Wide-field fundus image from infant ROP screening. Captured with the Phoenix ICON (100° field of view). Image size 1240x1240.
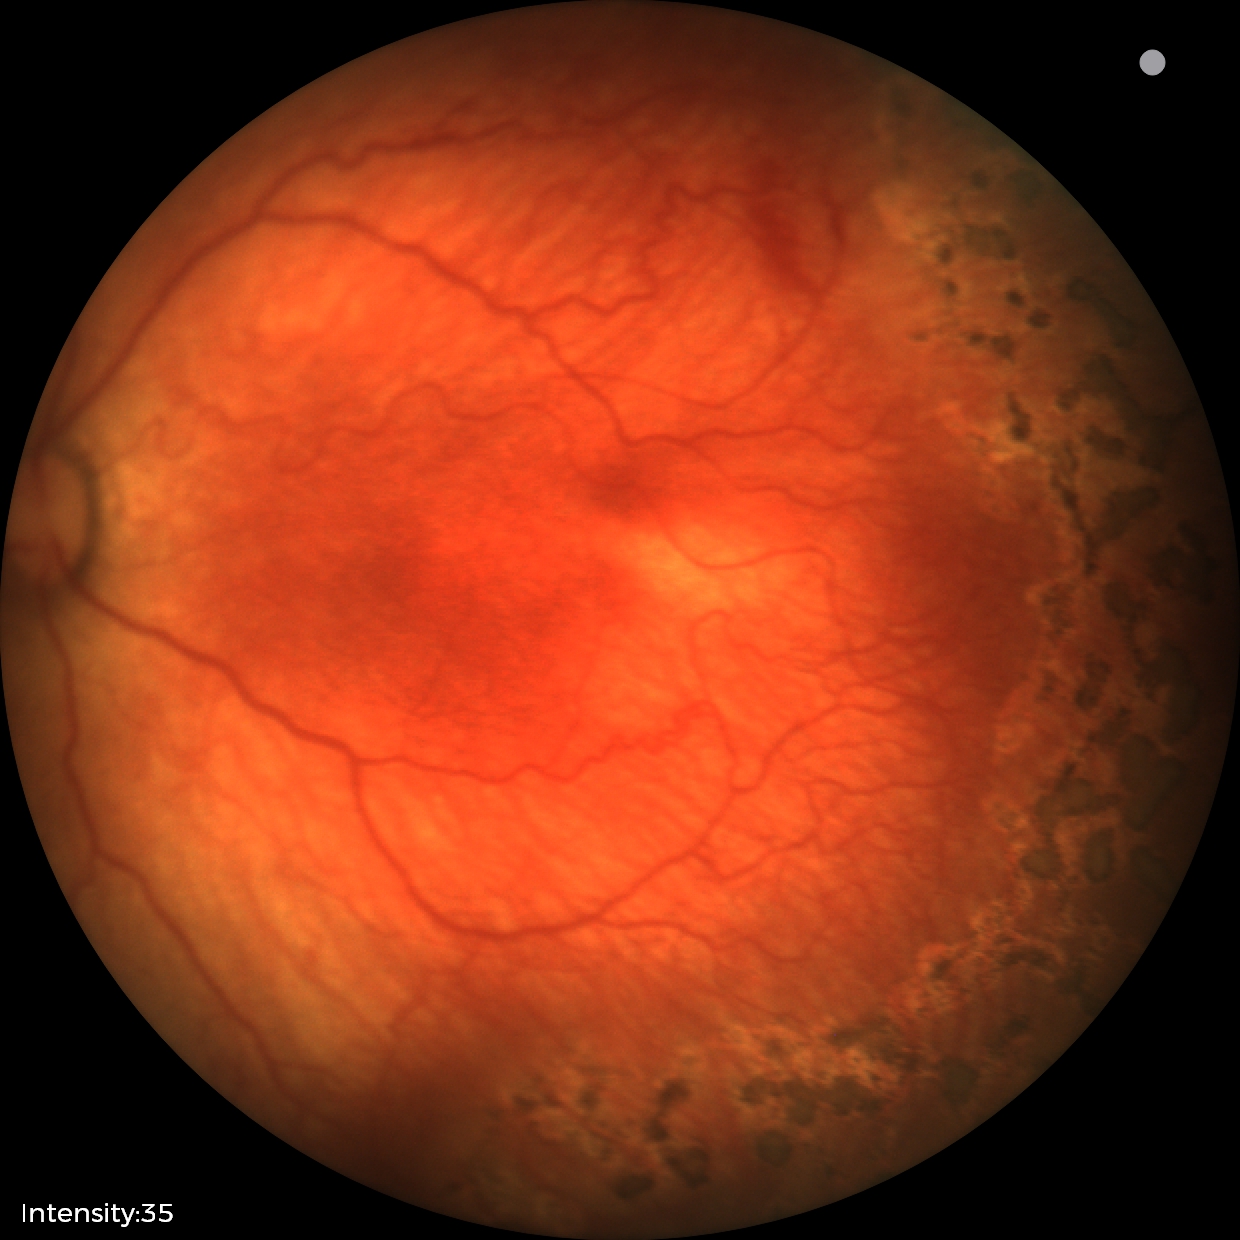
Diagnosis from this screening exam: ROP stage 1.